Color fundus photograph. 848x848px. FOV: 45 degrees. Nonmydriatic fundus photograph.
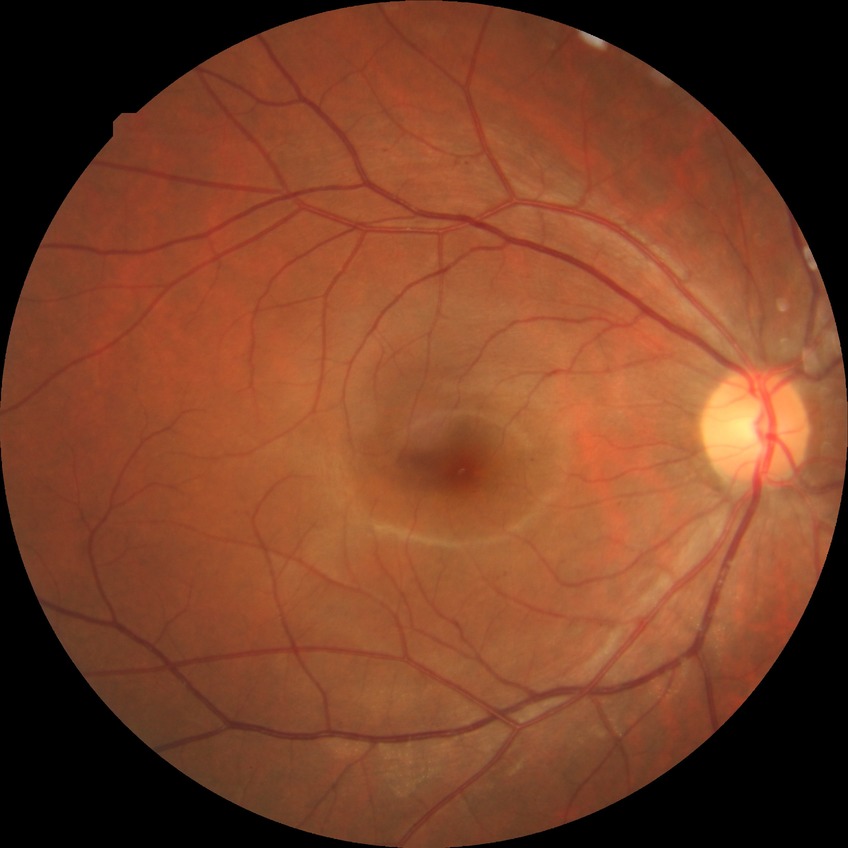

{
  "davis_grade": "SDR"
}